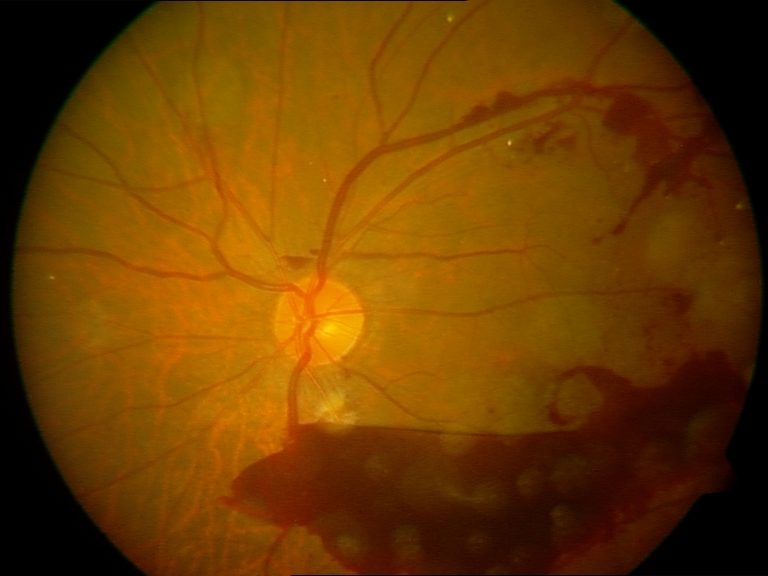 Classification: preretinal hemorrhage.